Disc-centered field · 240x240 — 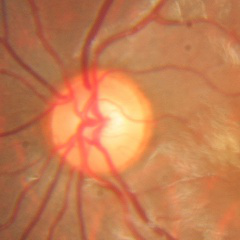 Optic disc appearance consistent with no glaucomatous optic neuropathy.